Color fundus image. Mydriatic (tropicamide phenylephrine 1.0%). 1932 by 1932 pixels: 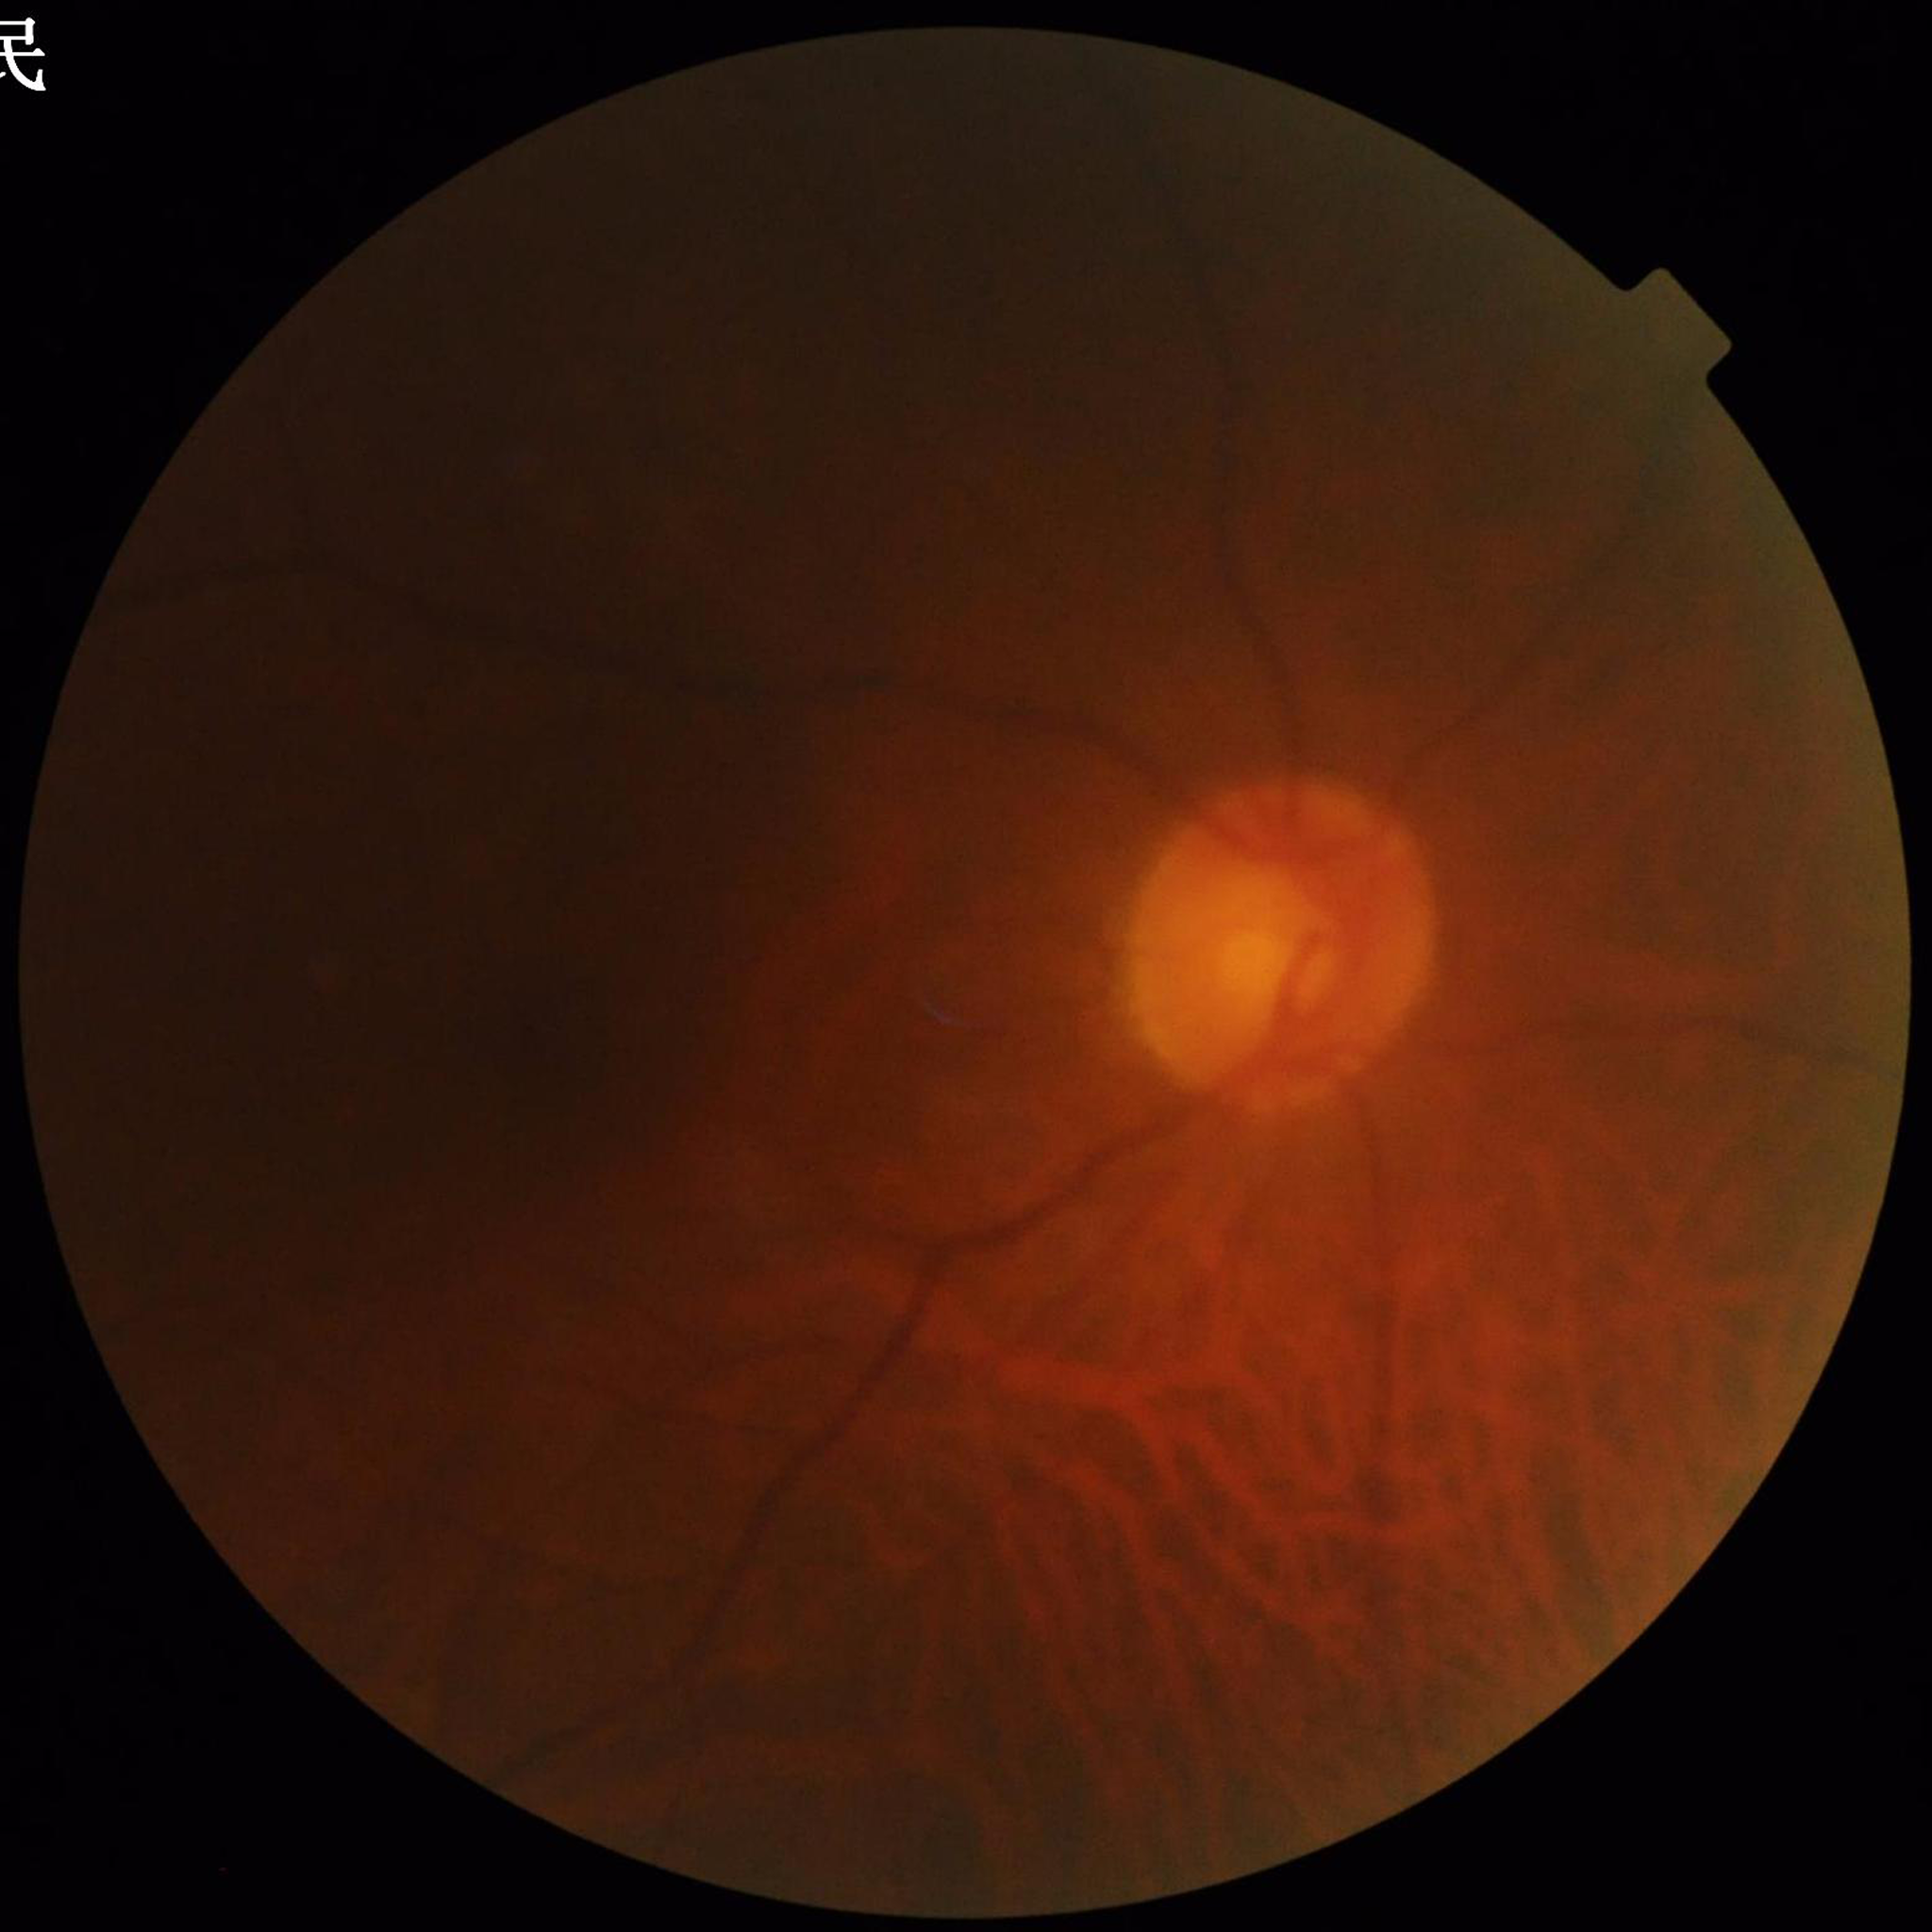 Eye affected by glaucoma.